Pediatric retinal photograph (wide-field). Captured with the Phoenix ICON (100° field of view). 1240x1240px: 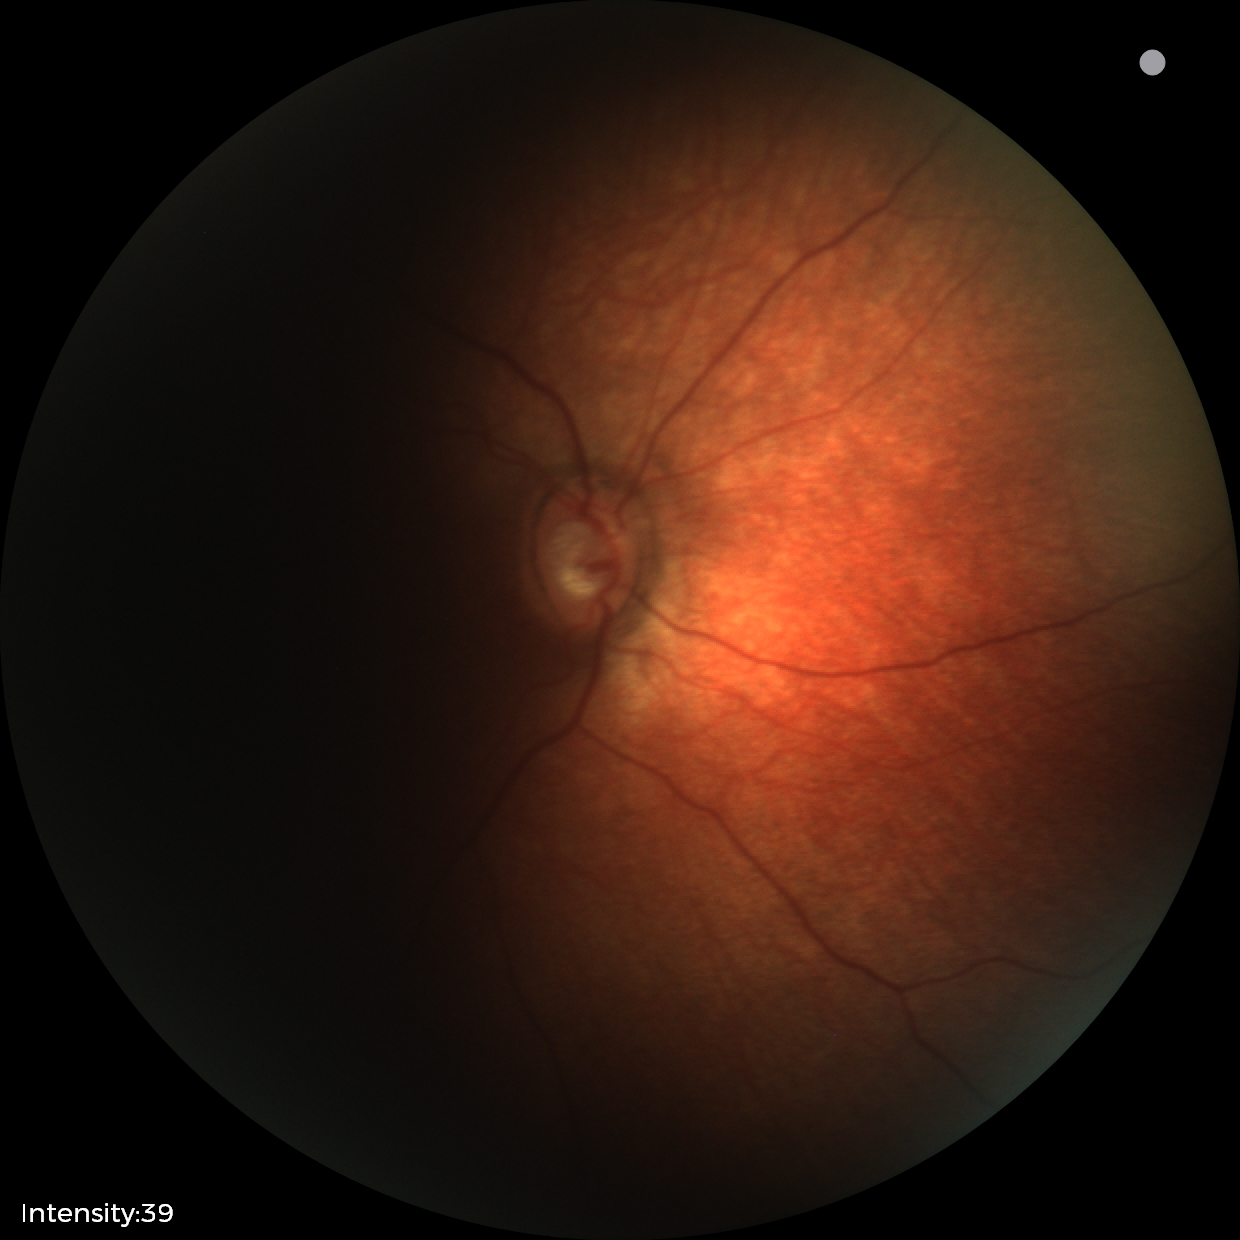

Q: What is the diagnosis from this examination?
A: physiological appearance with no retinal pathology